Acquired with a NIDEK AFC-230; 45° FOV; nonmydriatic fundus photograph; posterior pole photograph; 848 x 848 pixels: 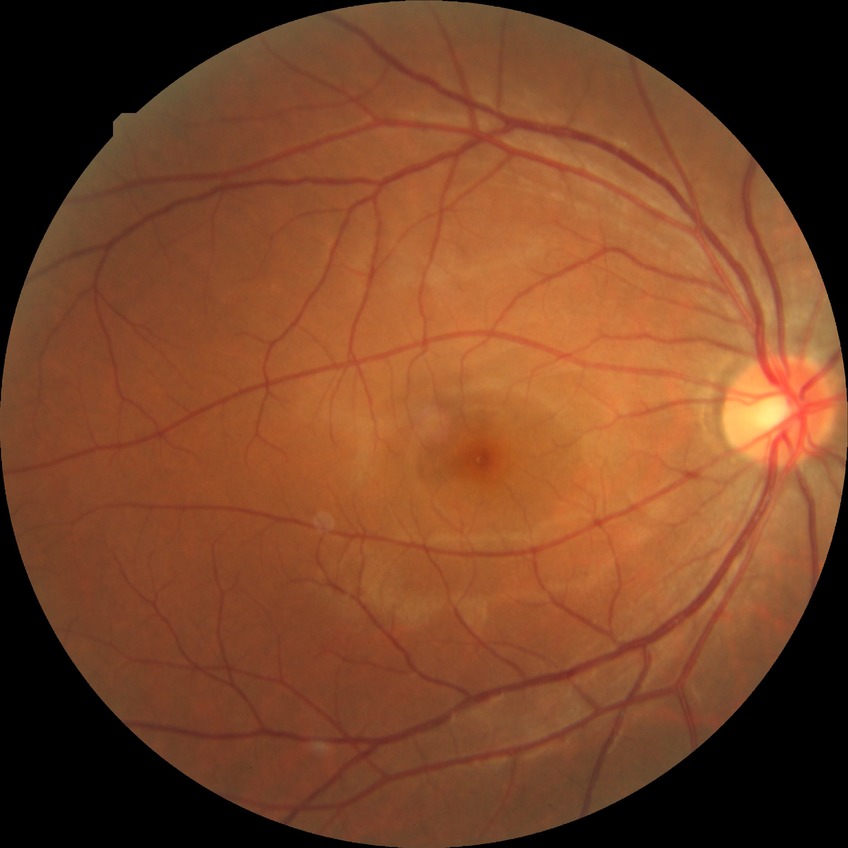
davis_grade: no diabetic retinopathy